FOV: 45 degrees; color fundus photograph; 2048 by 1536 pixels.
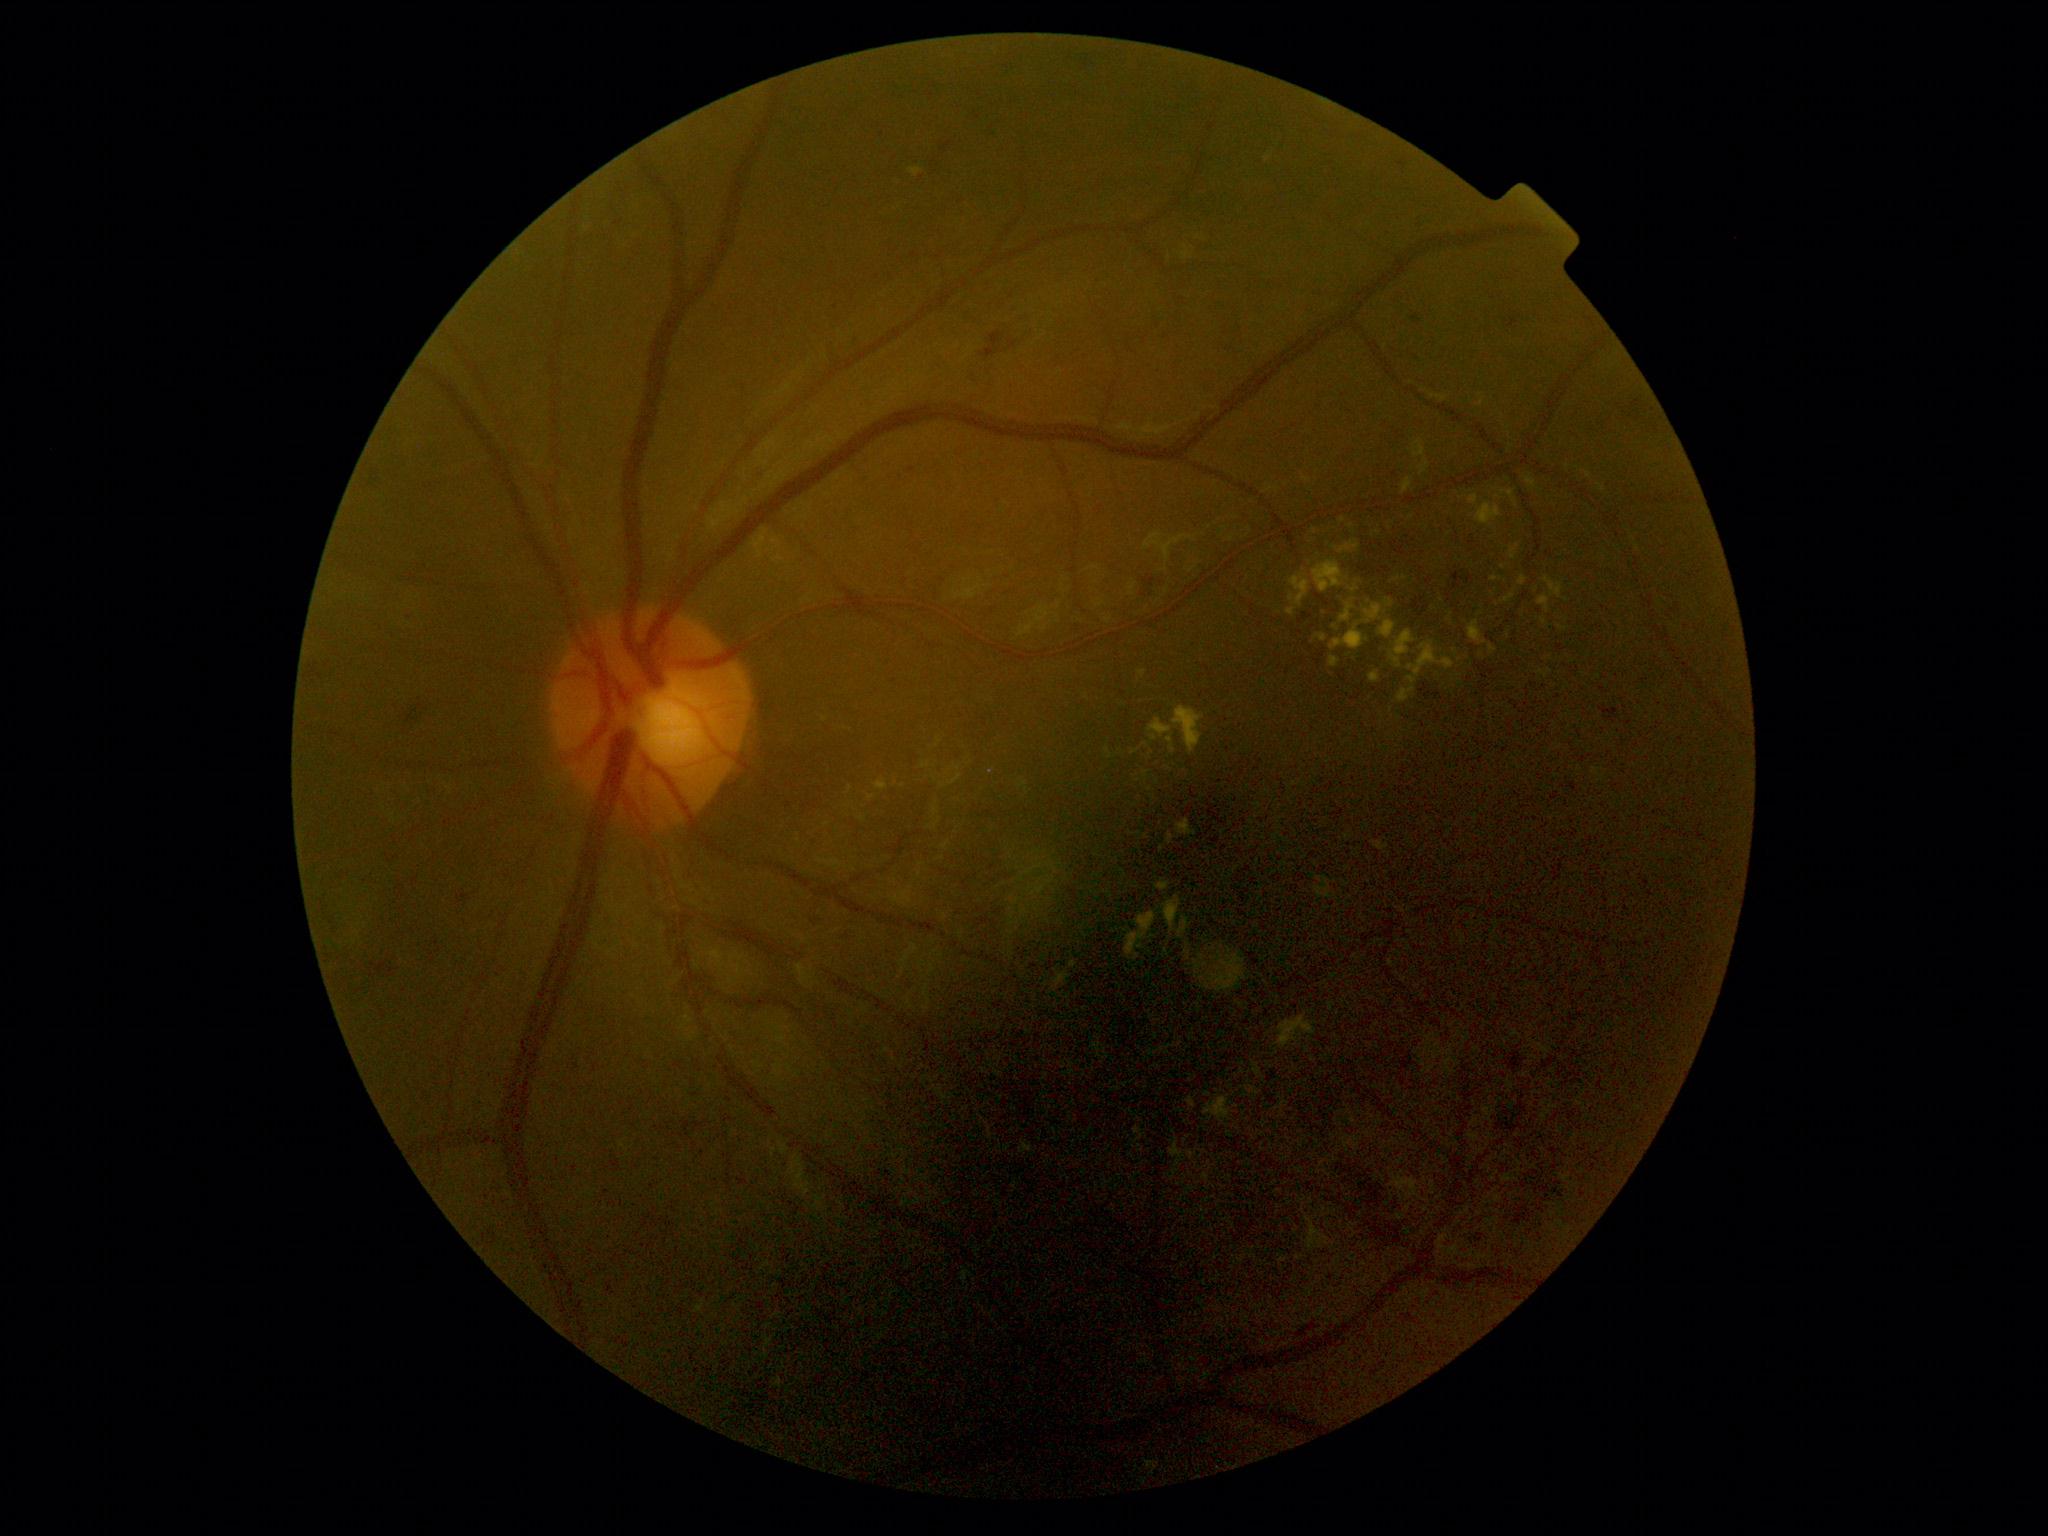

DR: moderate non-proliferative diabetic retinopathy (grade 2) — more than just microaneurysms but less than severe NPDR. No MAs identified. No SEs identified. EXs include lesions at 1335/540/1361/554 | 1387/600/1394/608 | 773/556/785/563 | 1330/625/1368/652 | 1369/671/1381/684 | 1163/896/1181/934 | 1401/478/1412/496 | 1247/1087/1260/1096 | 1341/603/1355/623 | 1408/642/1455/685 | 1519/576/1527/586. EXs (small, approximate centers) near pt(1146, 837) | pt(1508, 636) | pt(1198, 238) | pt(1169, 769) | pt(1269, 159) | pt(1442, 600) | pt(1146, 774). HEs include lesions at 1010/306/1026/319 | 1601/707/1619/724 | 908/467/917/474 | 1412/315/1422/326 | 1504/1050/1530/1083 | 1489/1100/1539/1146 | 1467/1227/1491/1258 | 1509/316/1520/329 | 1144/577/1155/588 | 1412/598/1425/612 | 1323/1159/1395/1214 | 1398/161/1407/171 | 453/888/484/908 | 364/467/384/488. HEs (small, approximate centers) near pt(1656, 430) | pt(936, 164) | pt(1145, 596) | pt(1638, 413) | pt(1012, 297) | pt(1507, 321).